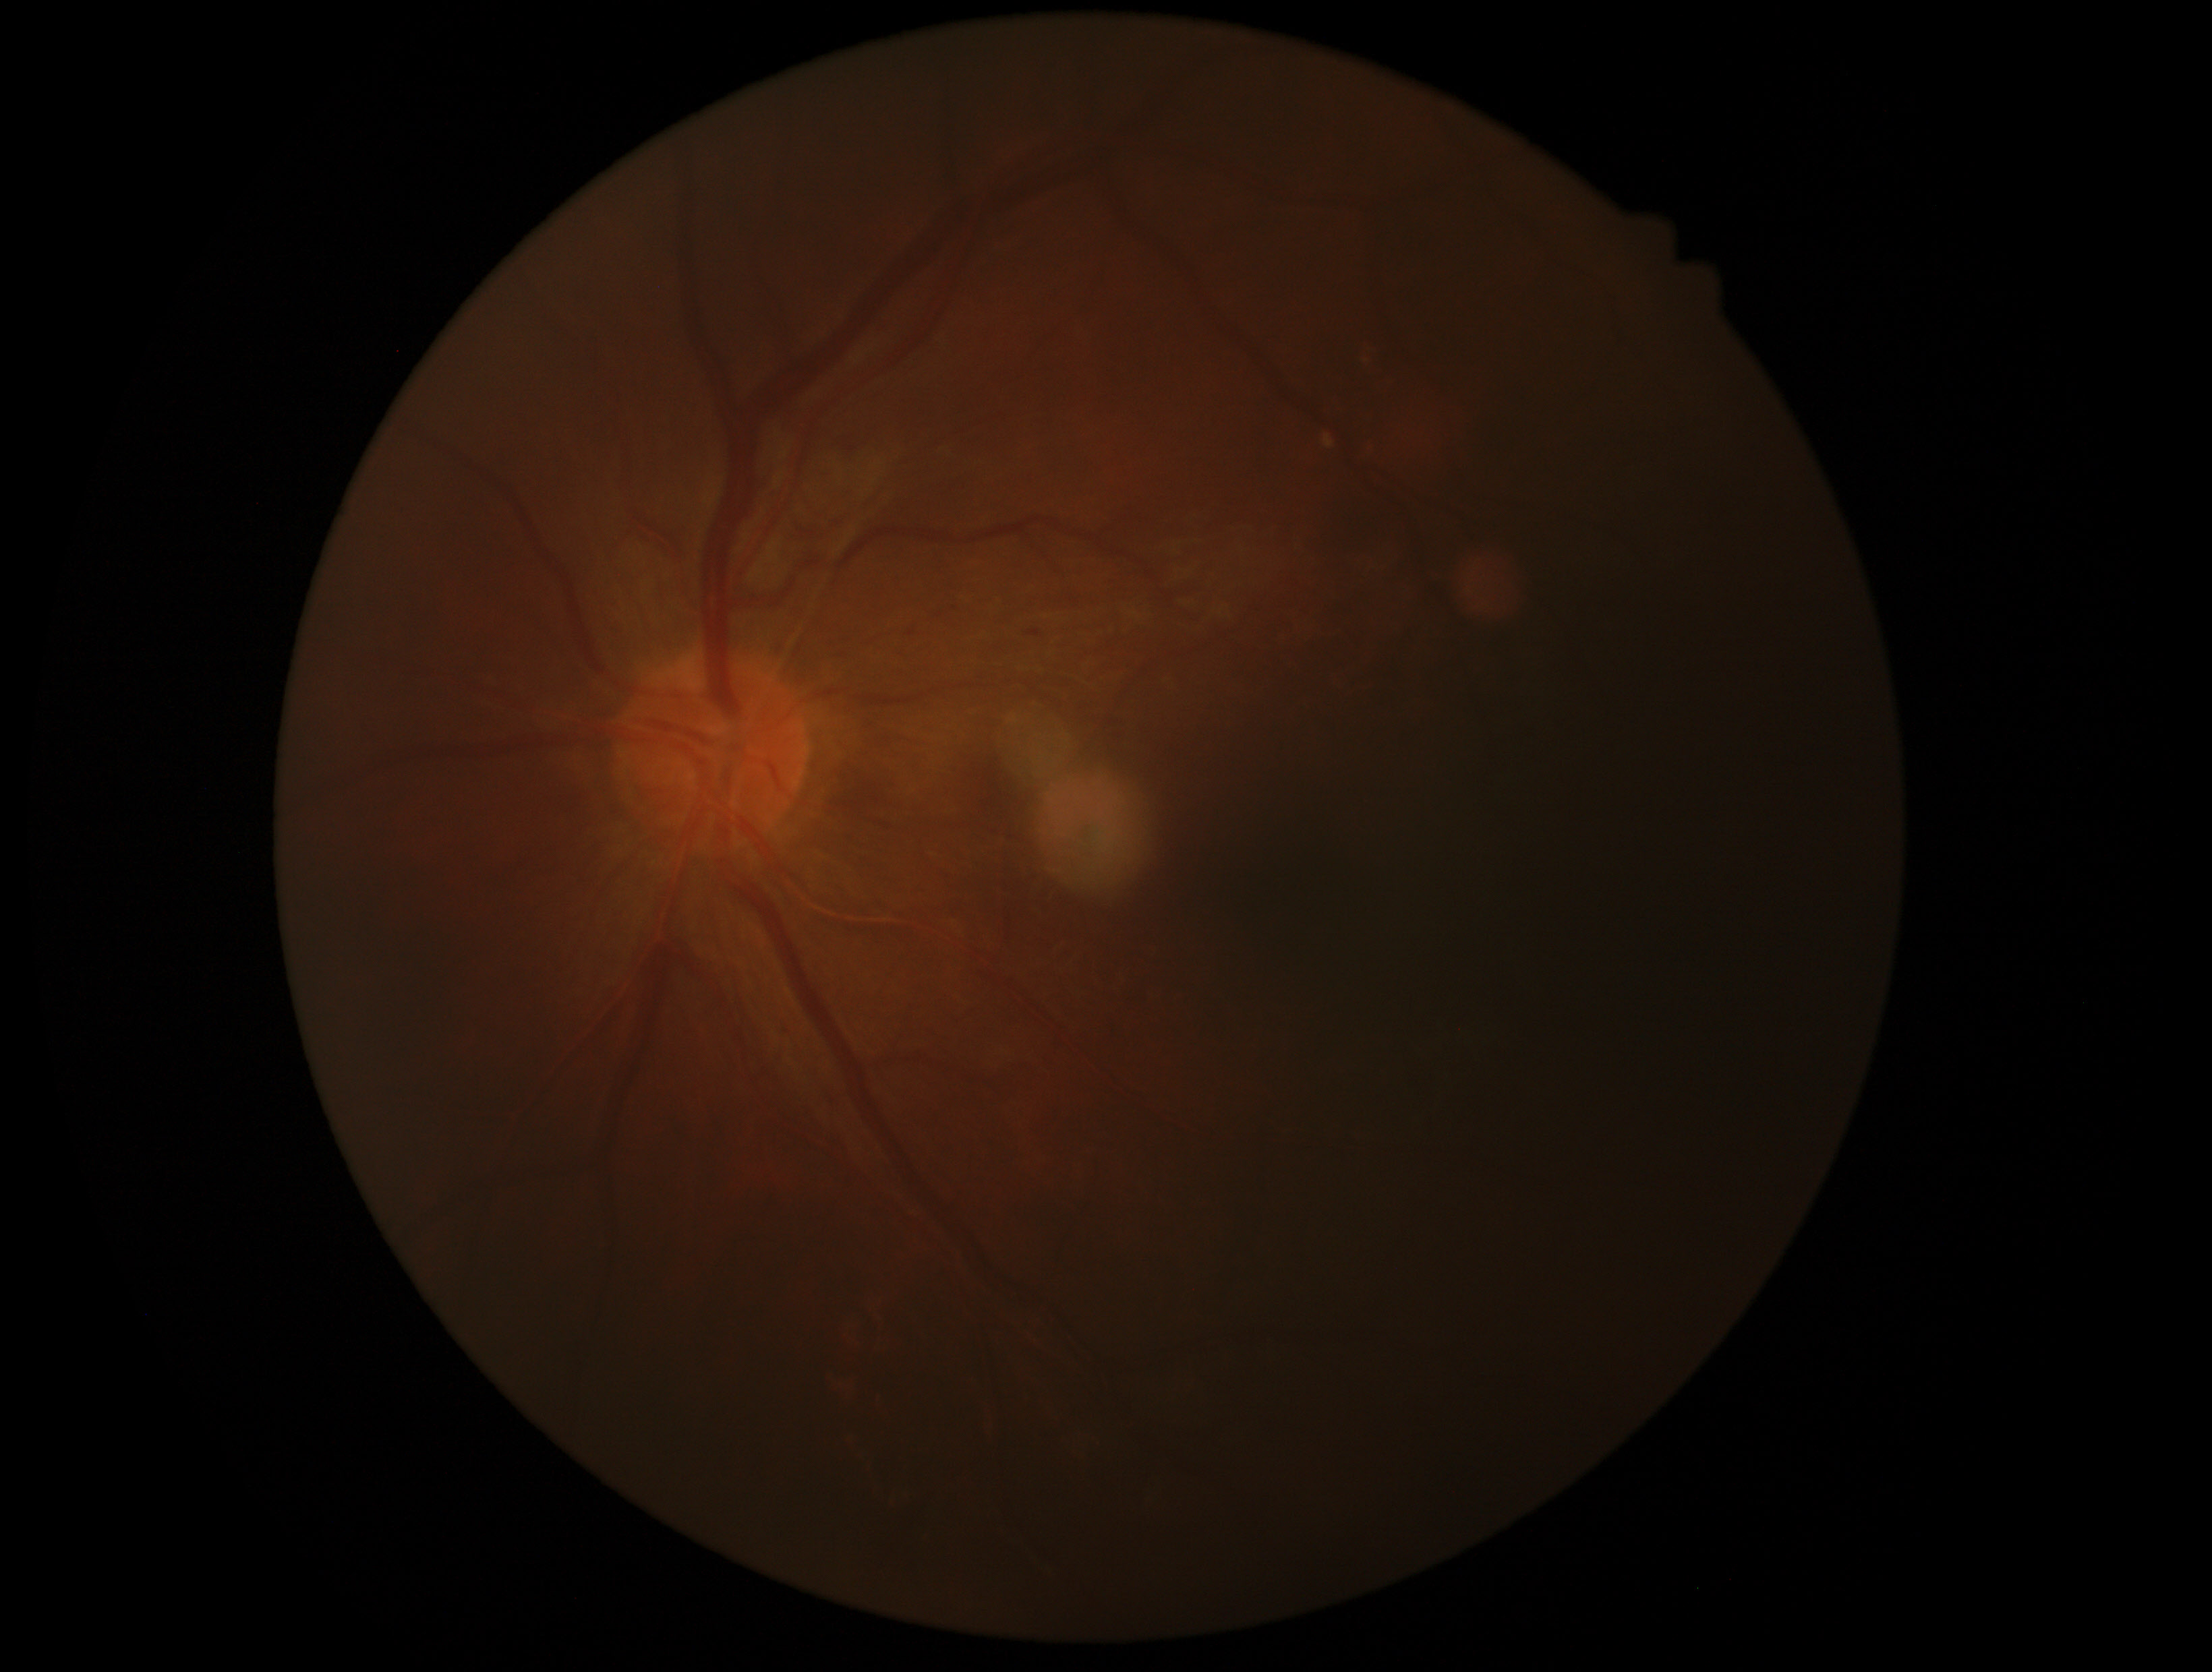
{
  "dr_grade": "grade 2"
}